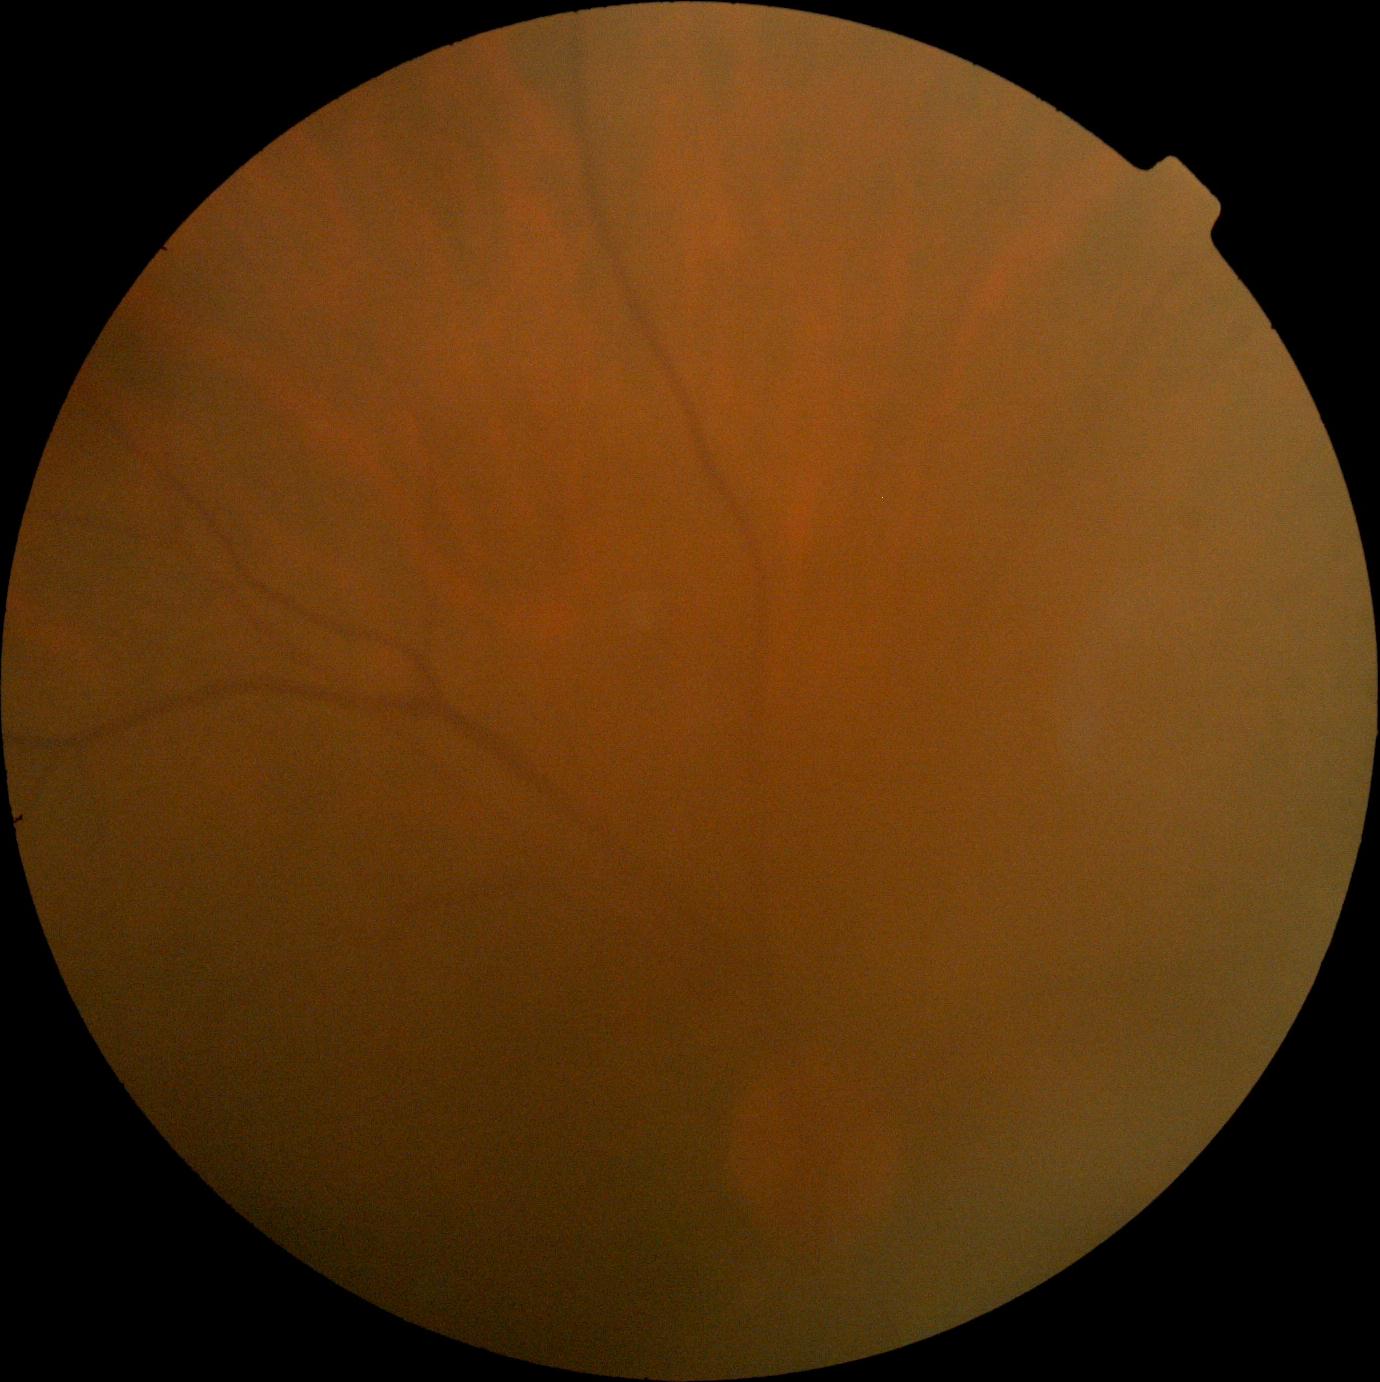

image quality: below grading threshold, DR stage: ungradable.